Pediatric wide-field fundus photograph · 640x480px.
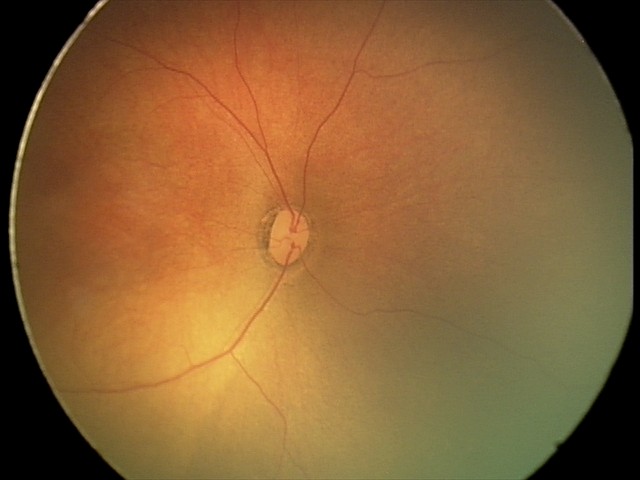

Screening: normal retinal appearance.